Optic nerve head crop.
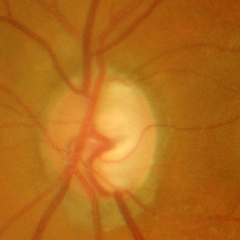
Glaucoma diagnosis: advanced glaucoma.